Camera: Natus RetCam Envision (130° FOV) · 1440x1080 · wide-field fundus image from infant ROP screening: 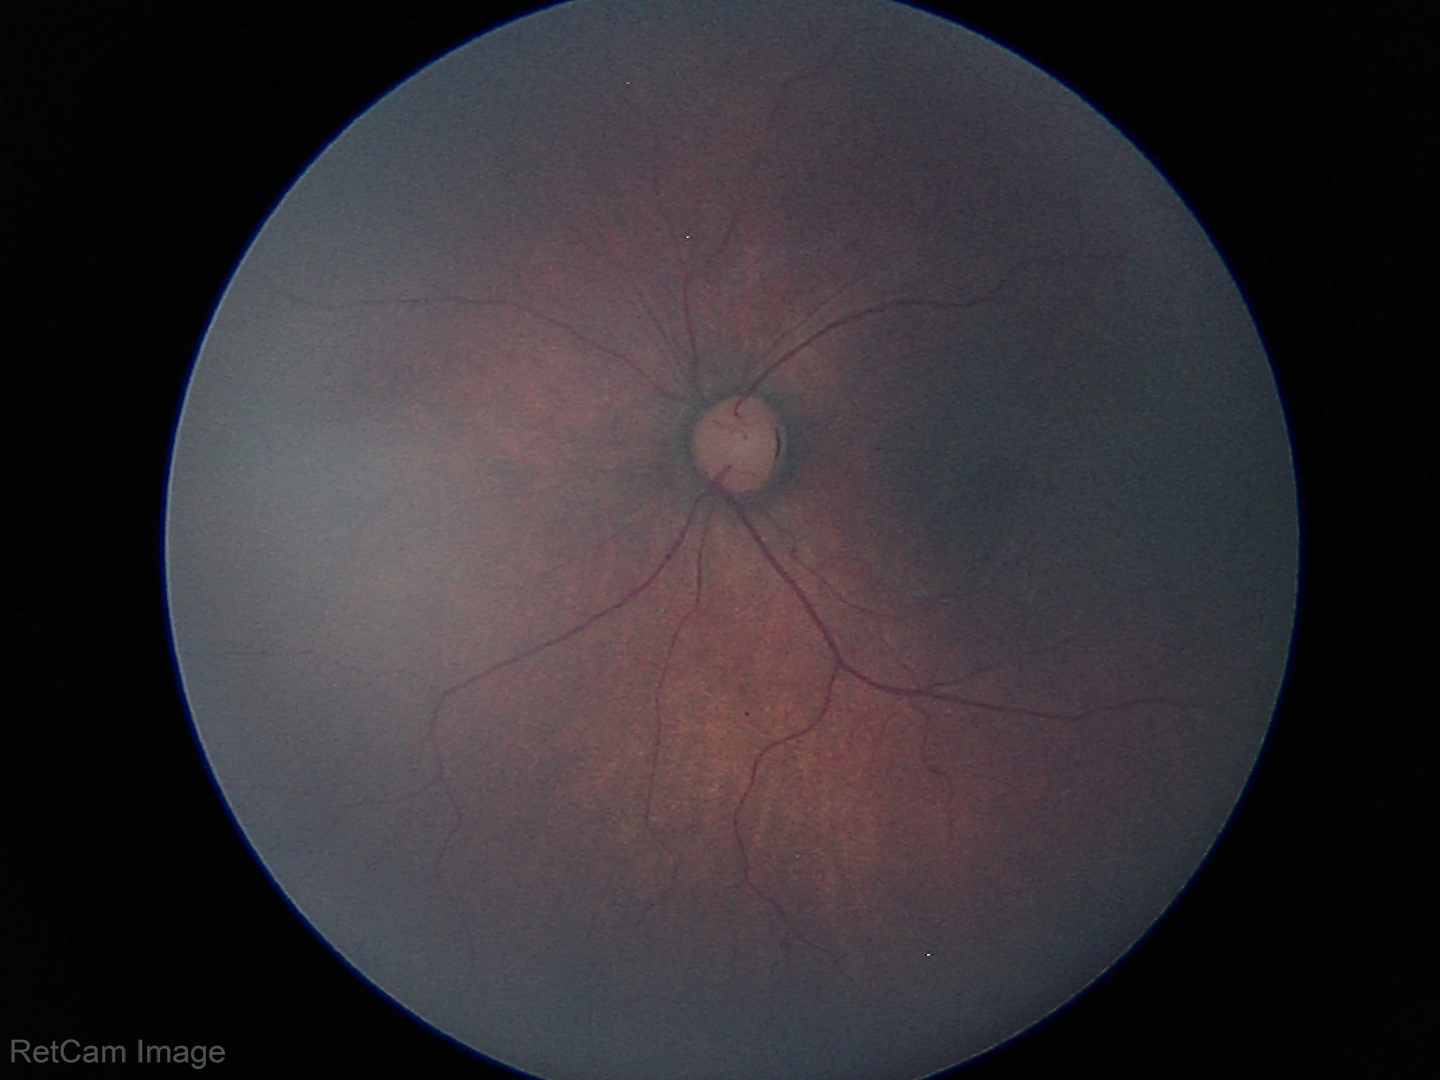

Impression: normal retinal appearance.